45-degree field of view.
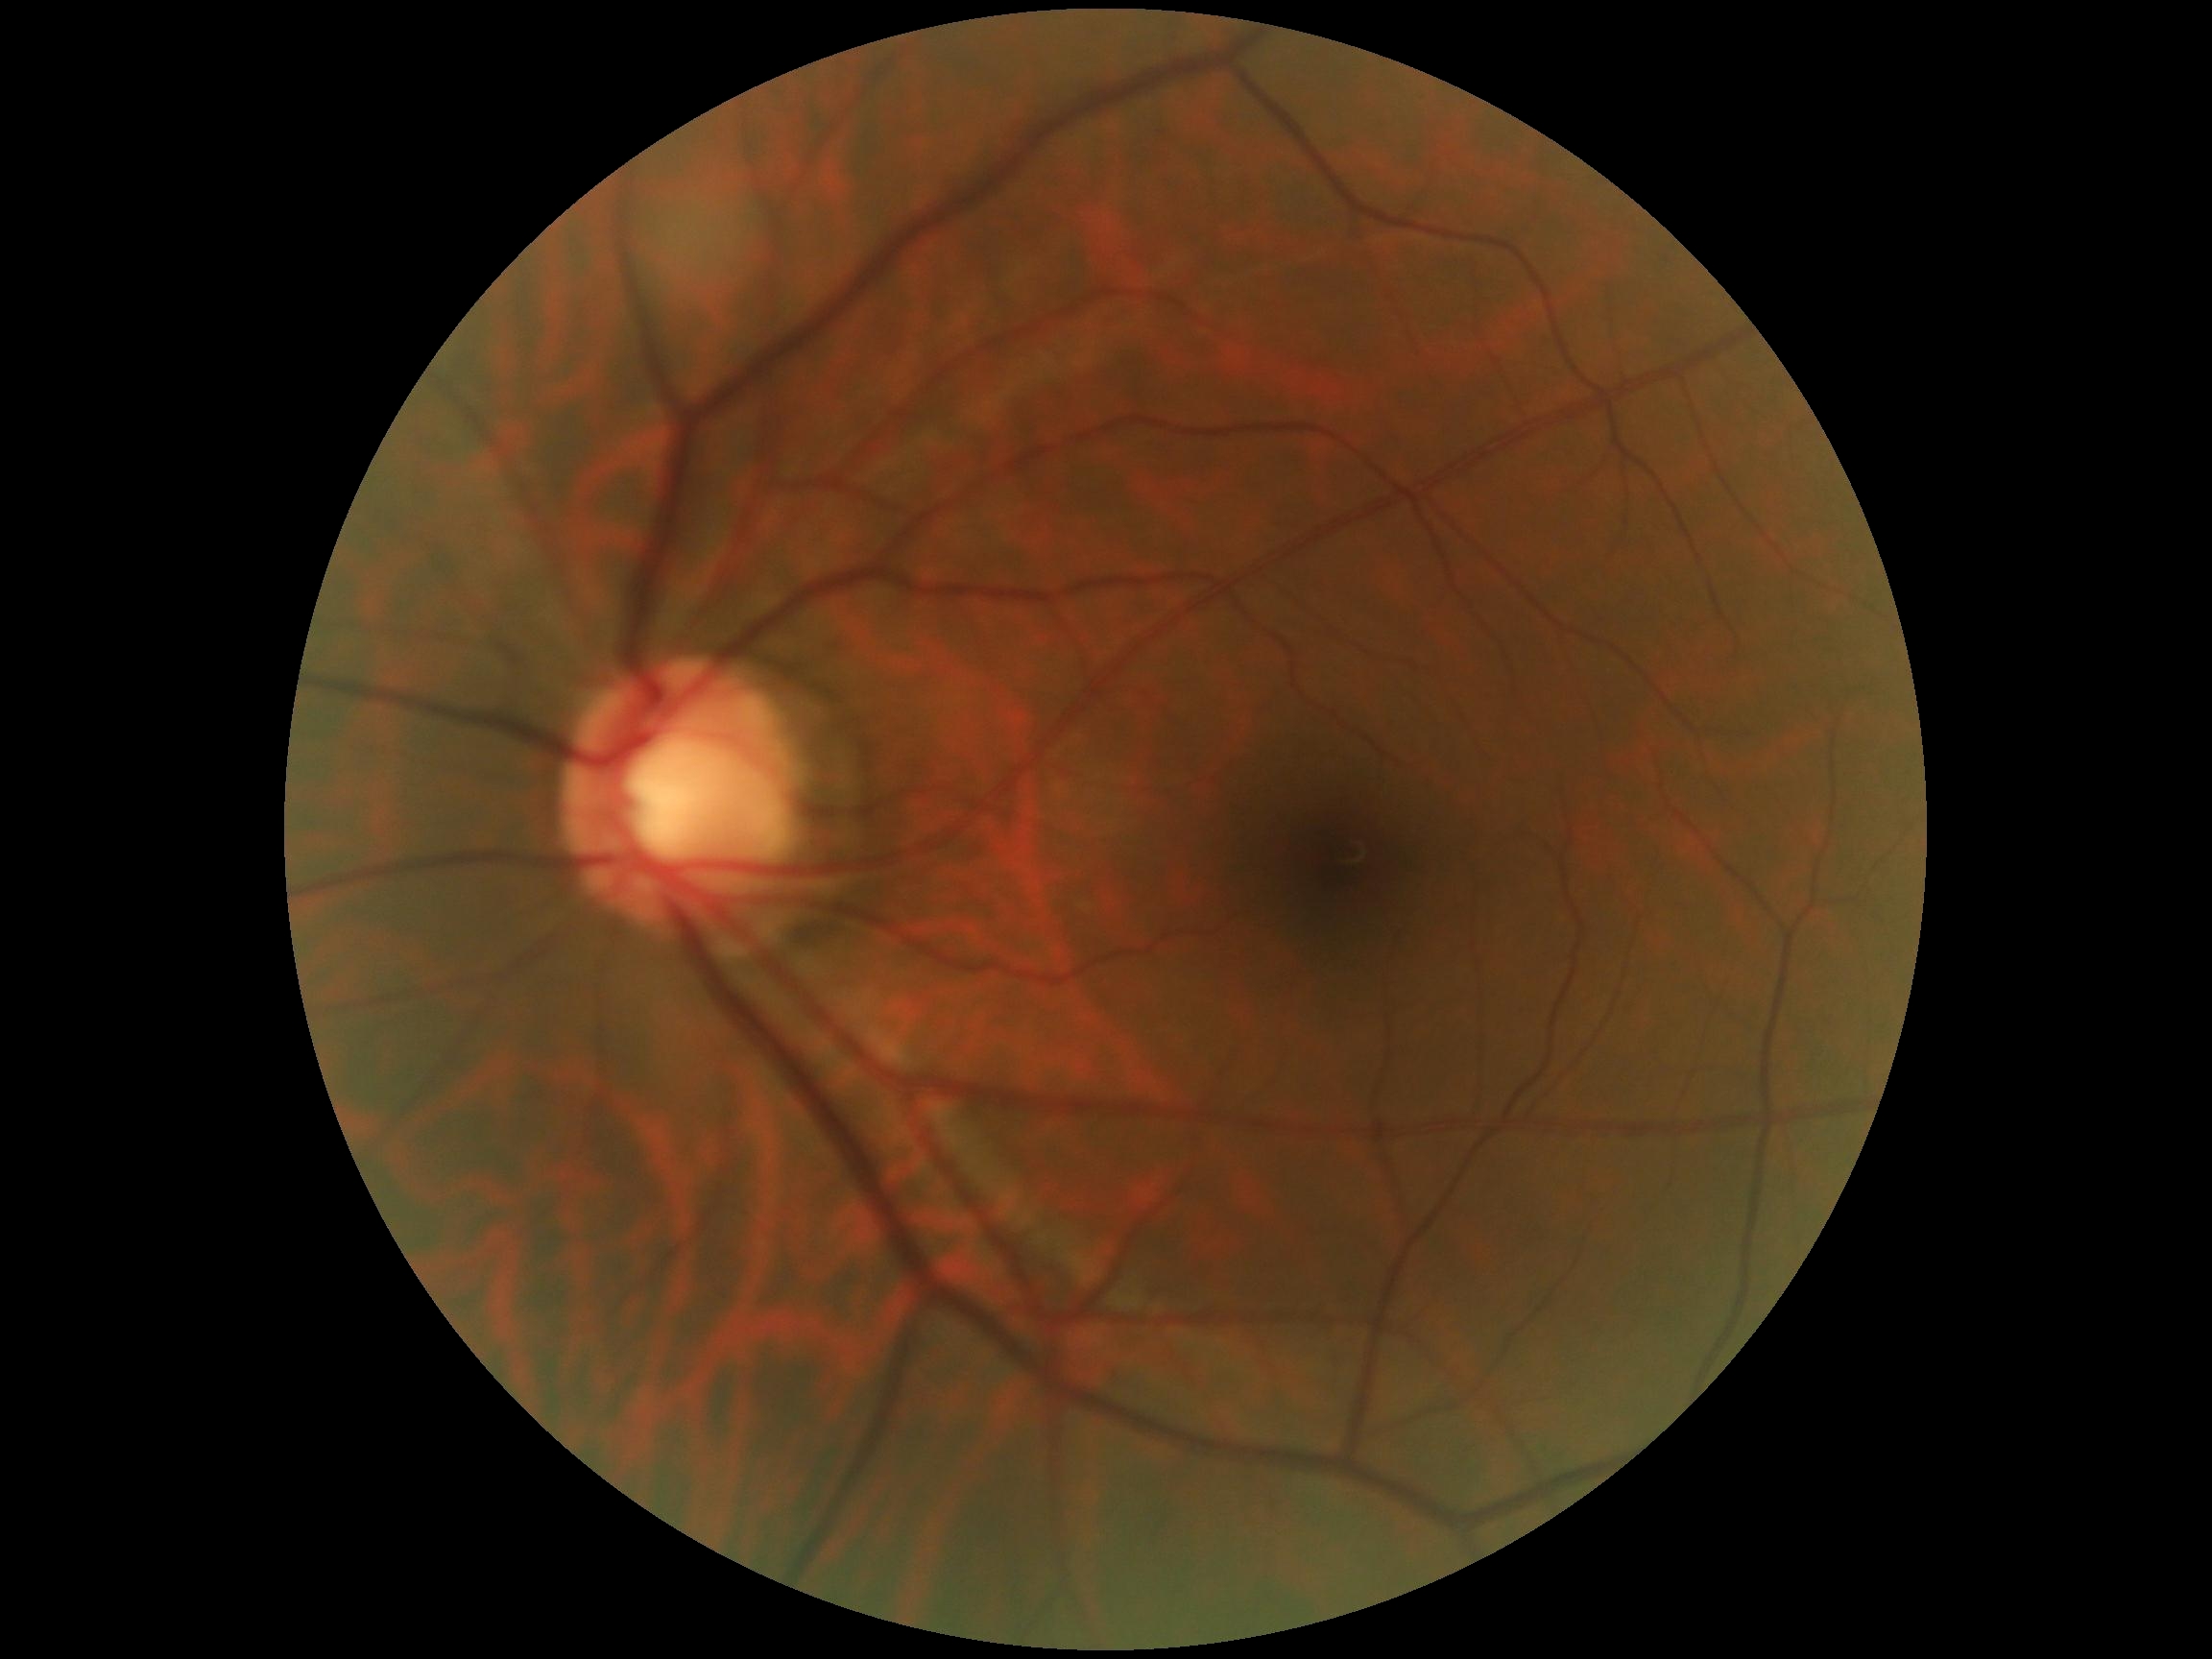 {
  "dr_grade": "0 (no apparent retinopathy)"
}